2352x1568
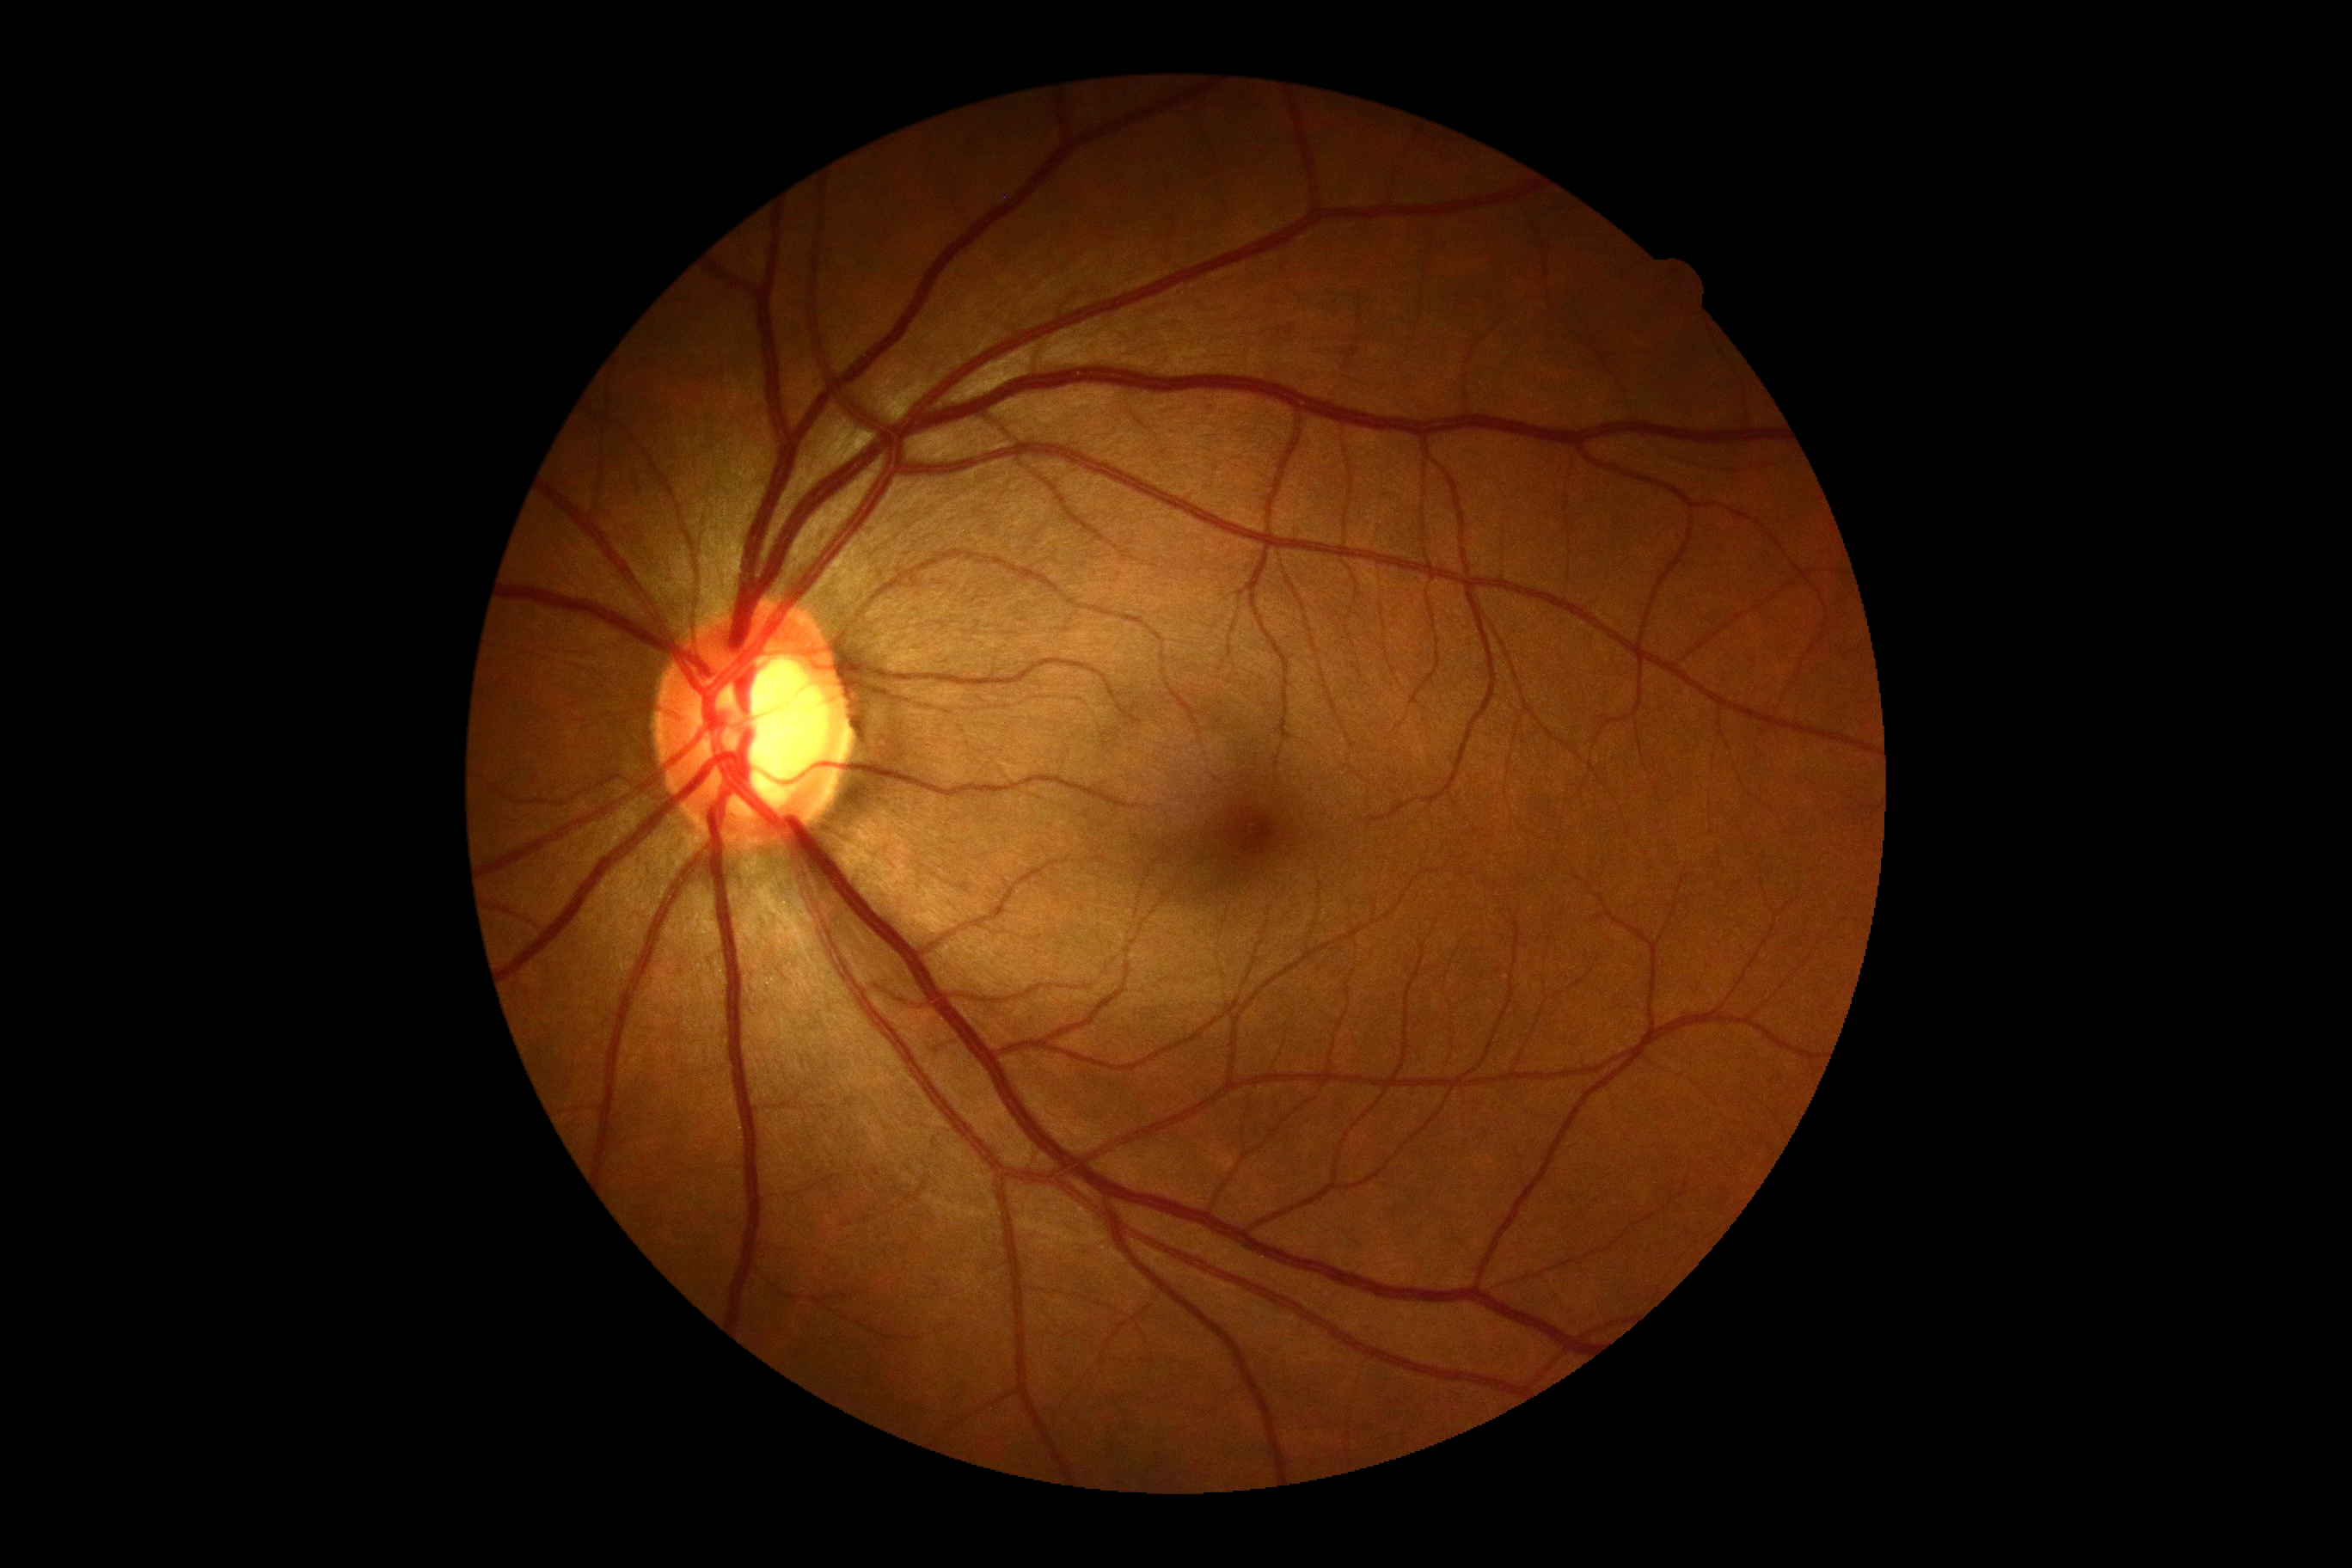

DR is 0.